Modified Davis classification:
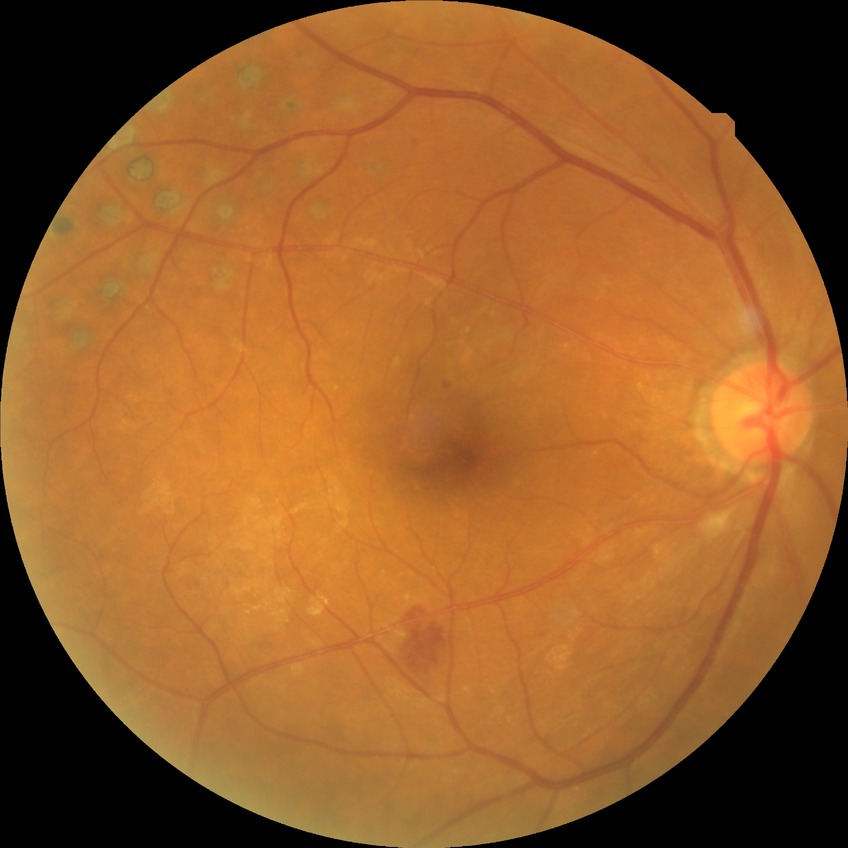
Assessment:
* DR grade — PDR